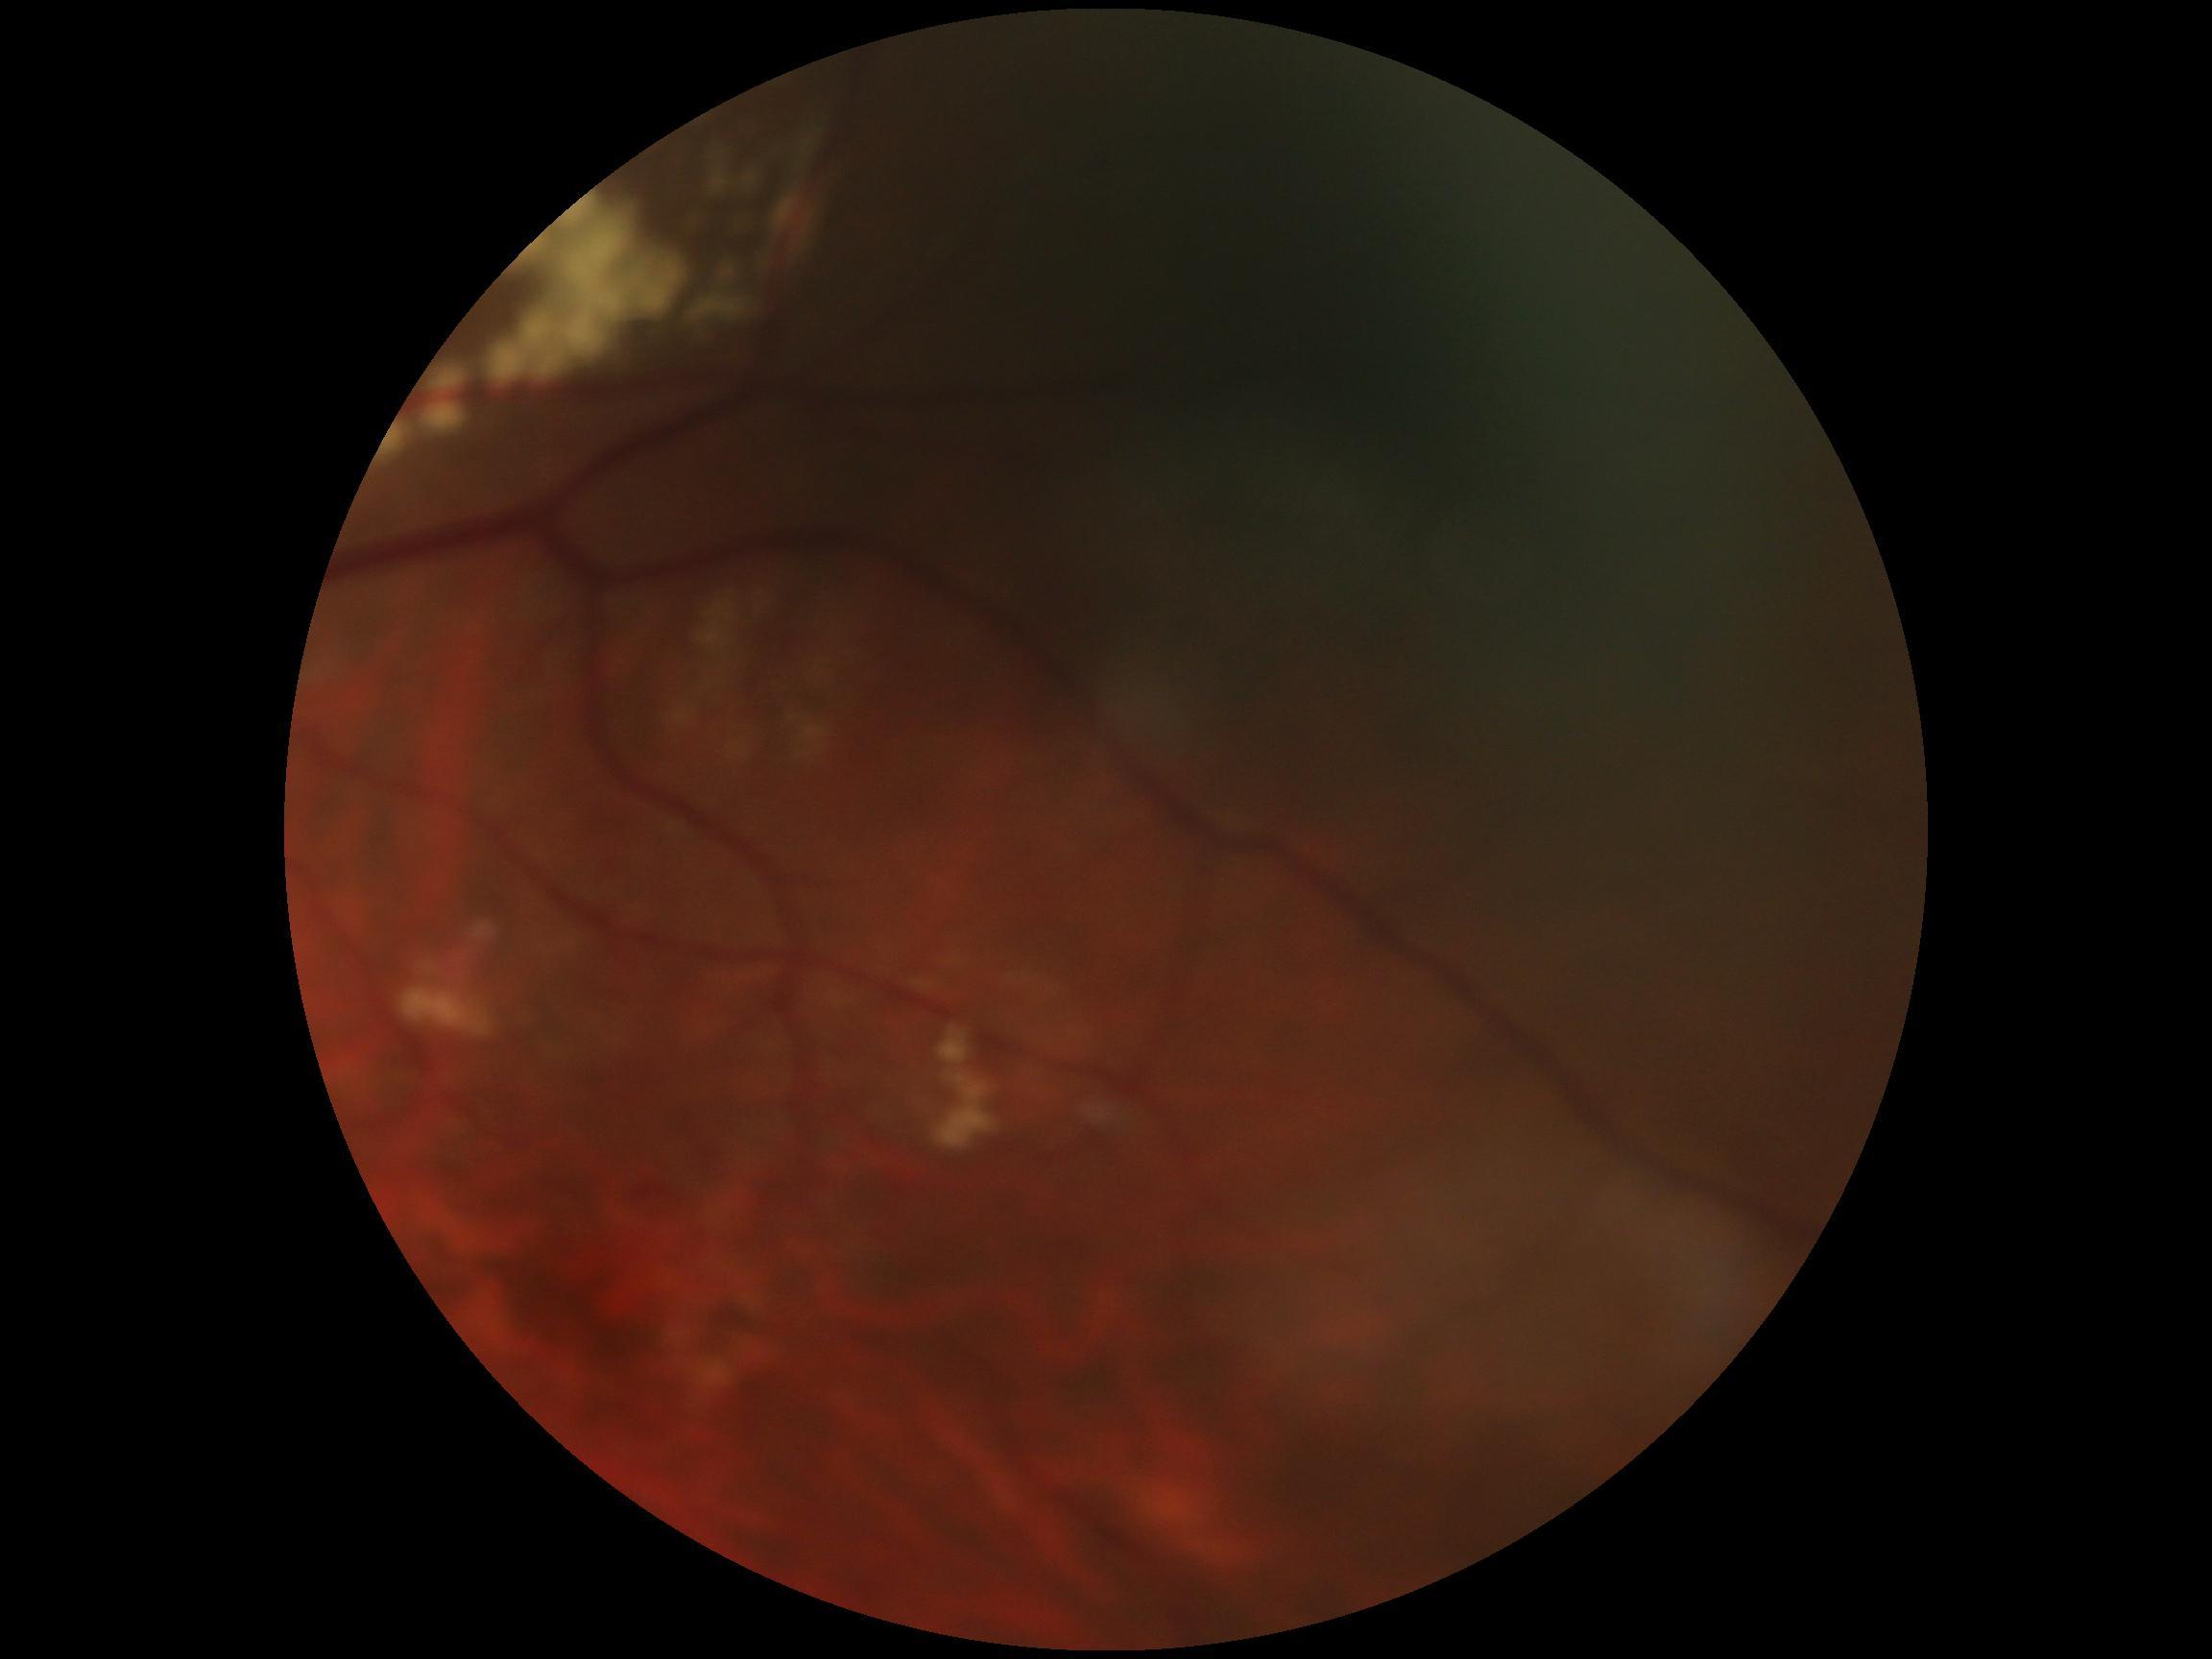
DR grade is ungradable.